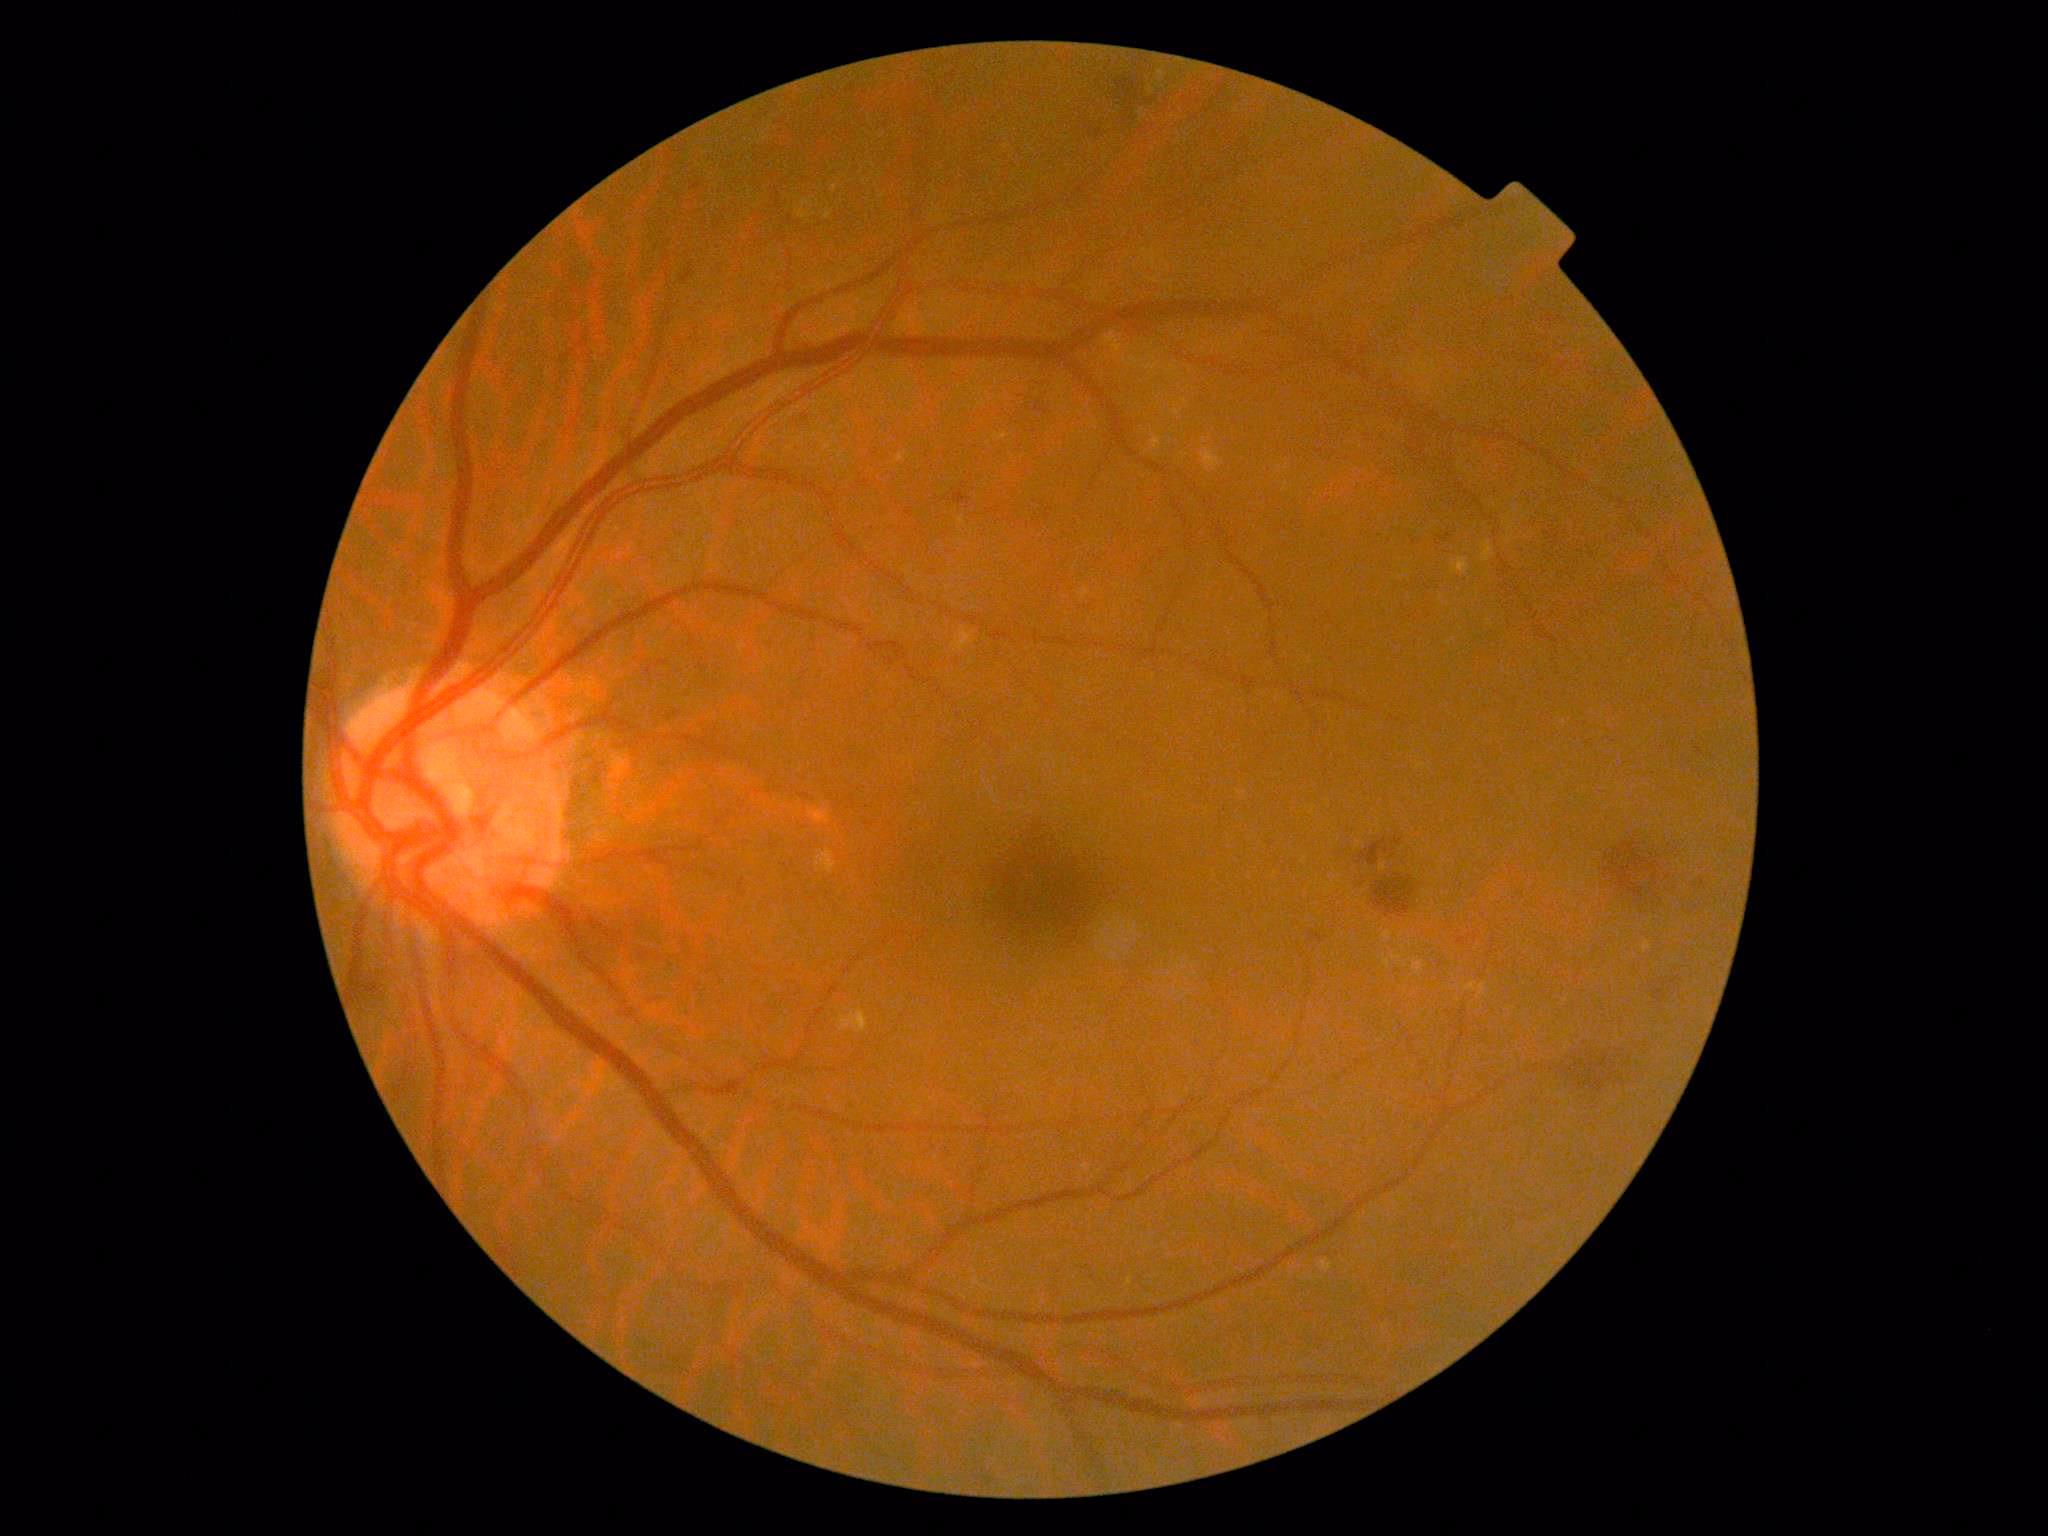
DR severity is 2/4.